2352x1568px: 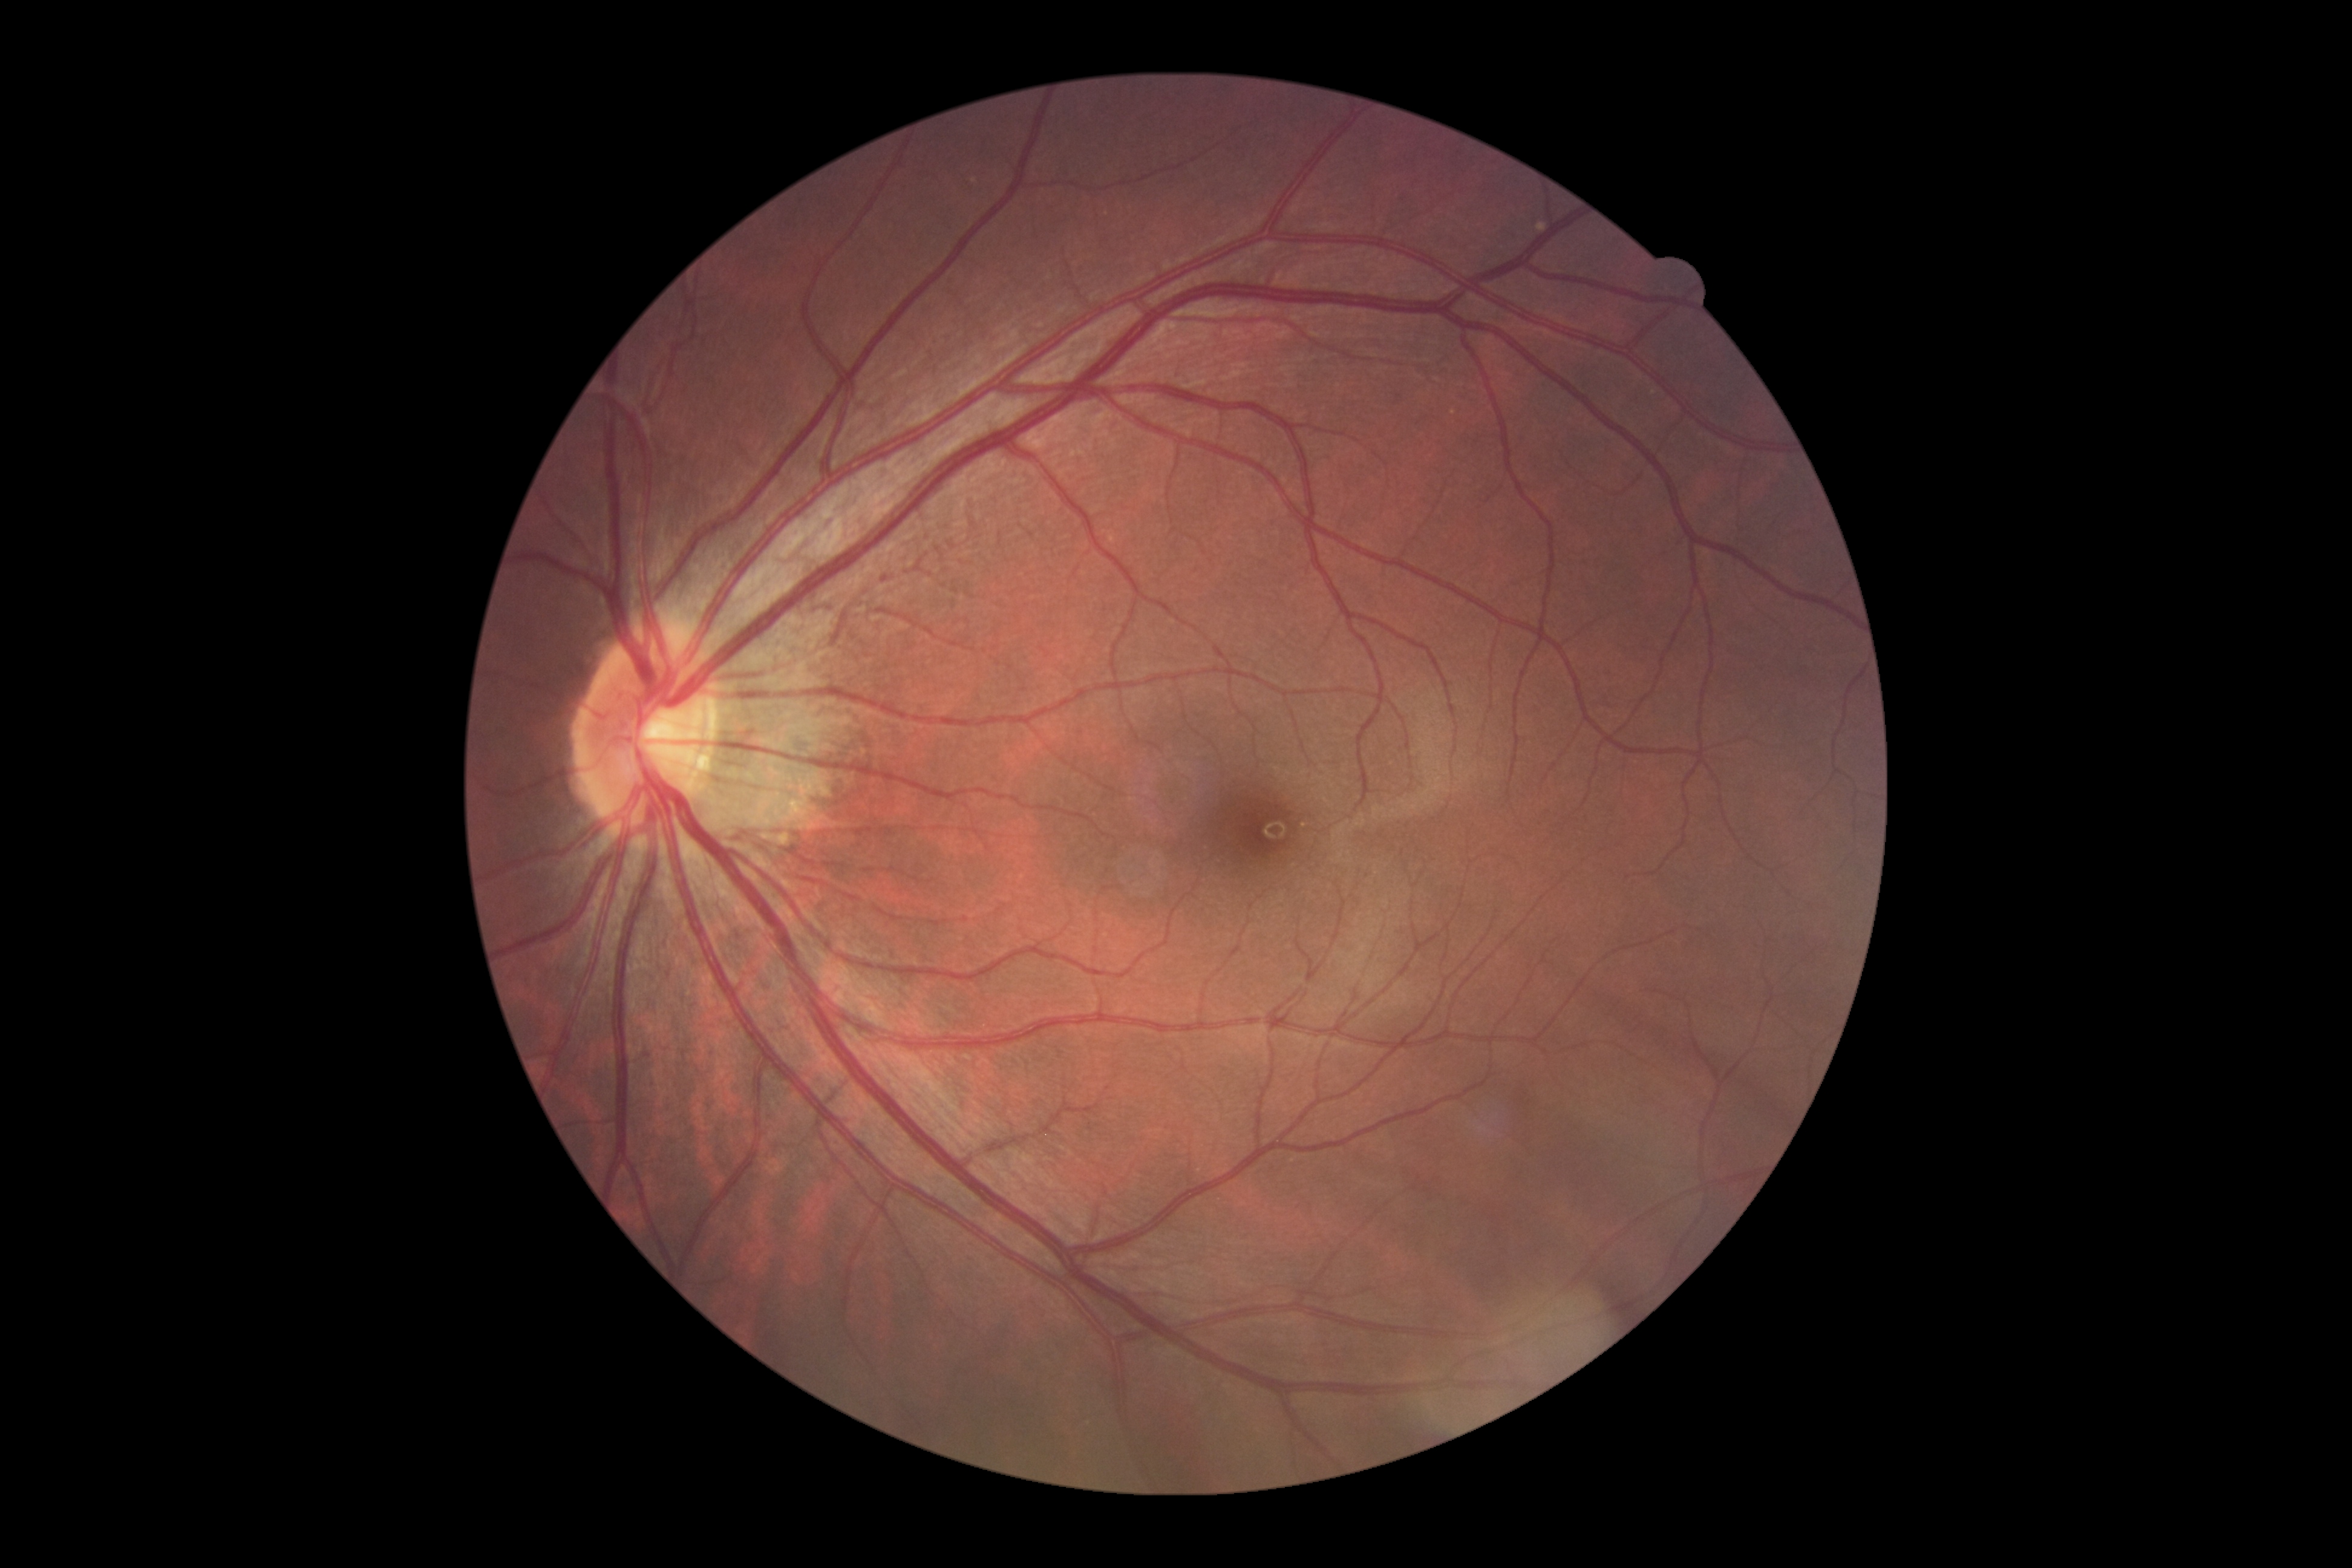 Findings:
* DR stage: grade 0 — no visible signs of diabetic retinopathy